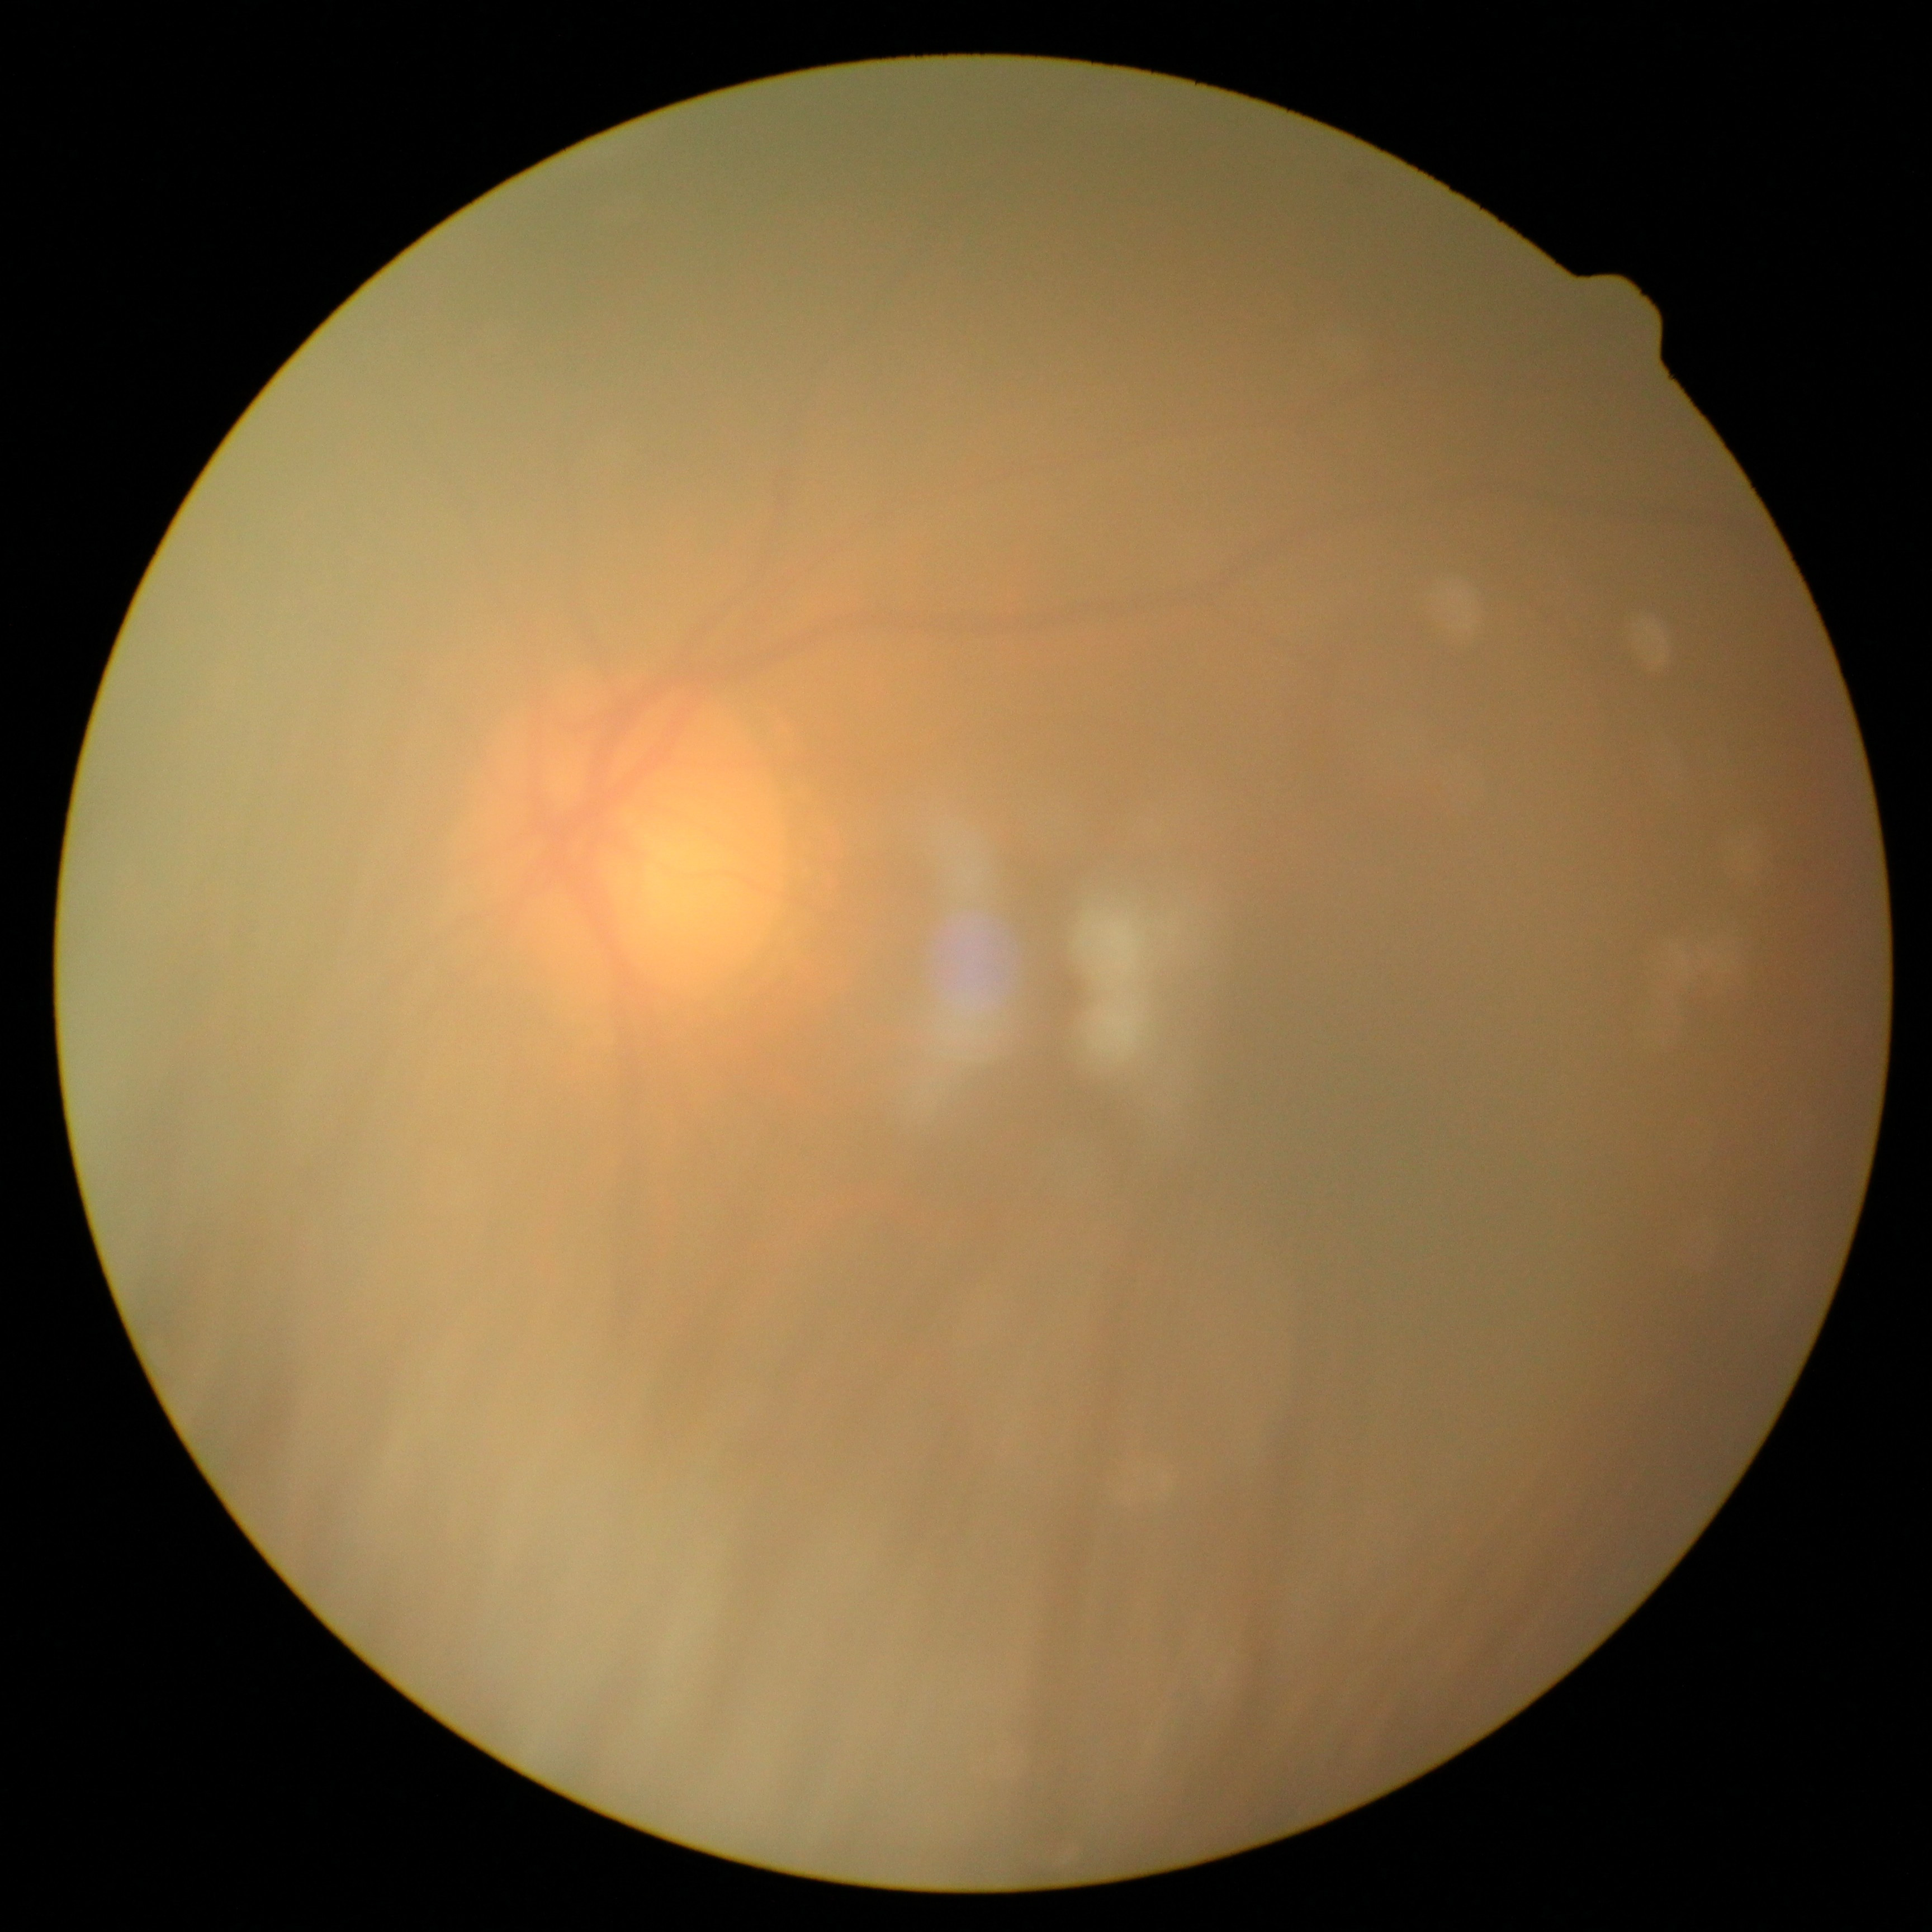
Diabetic retinopathy grade: ungradable.
Ungradable image — DR severity cannot be determined.